45° field of view.
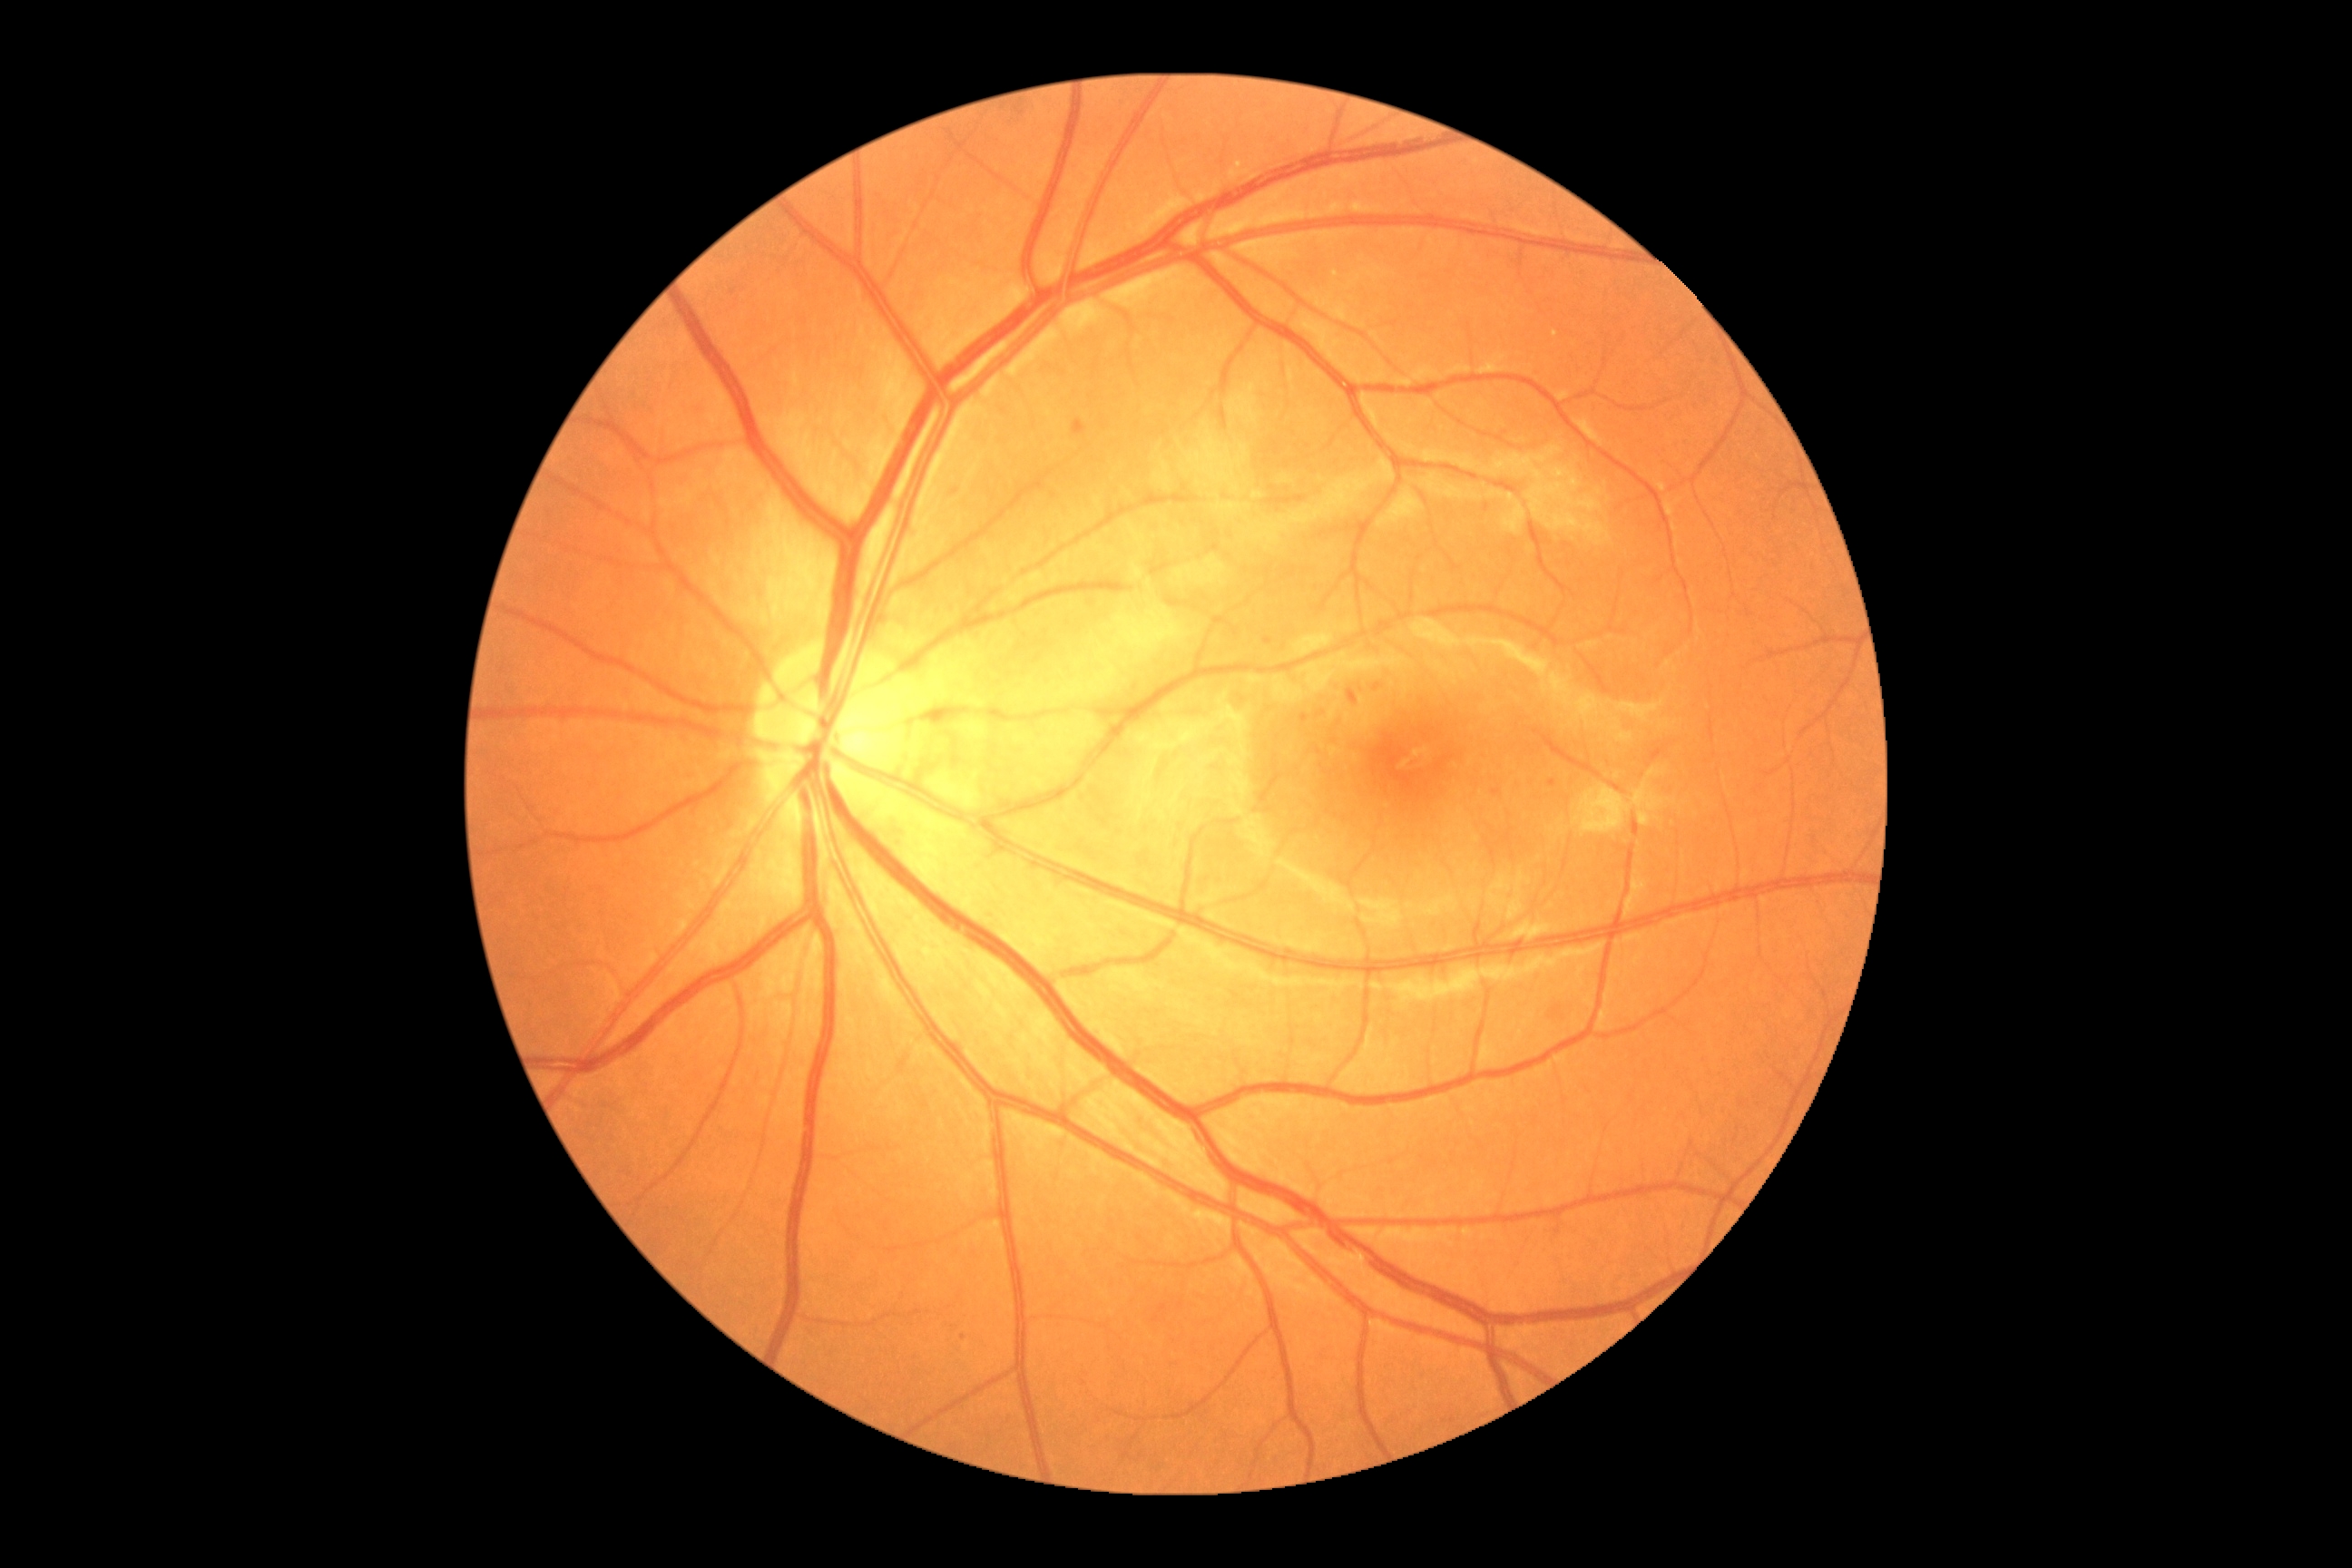
DR severity is grade 2 (moderate NPDR). Disease class: non-proliferative diabetic retinopathy.